Axial length (AL): 22.69 mm
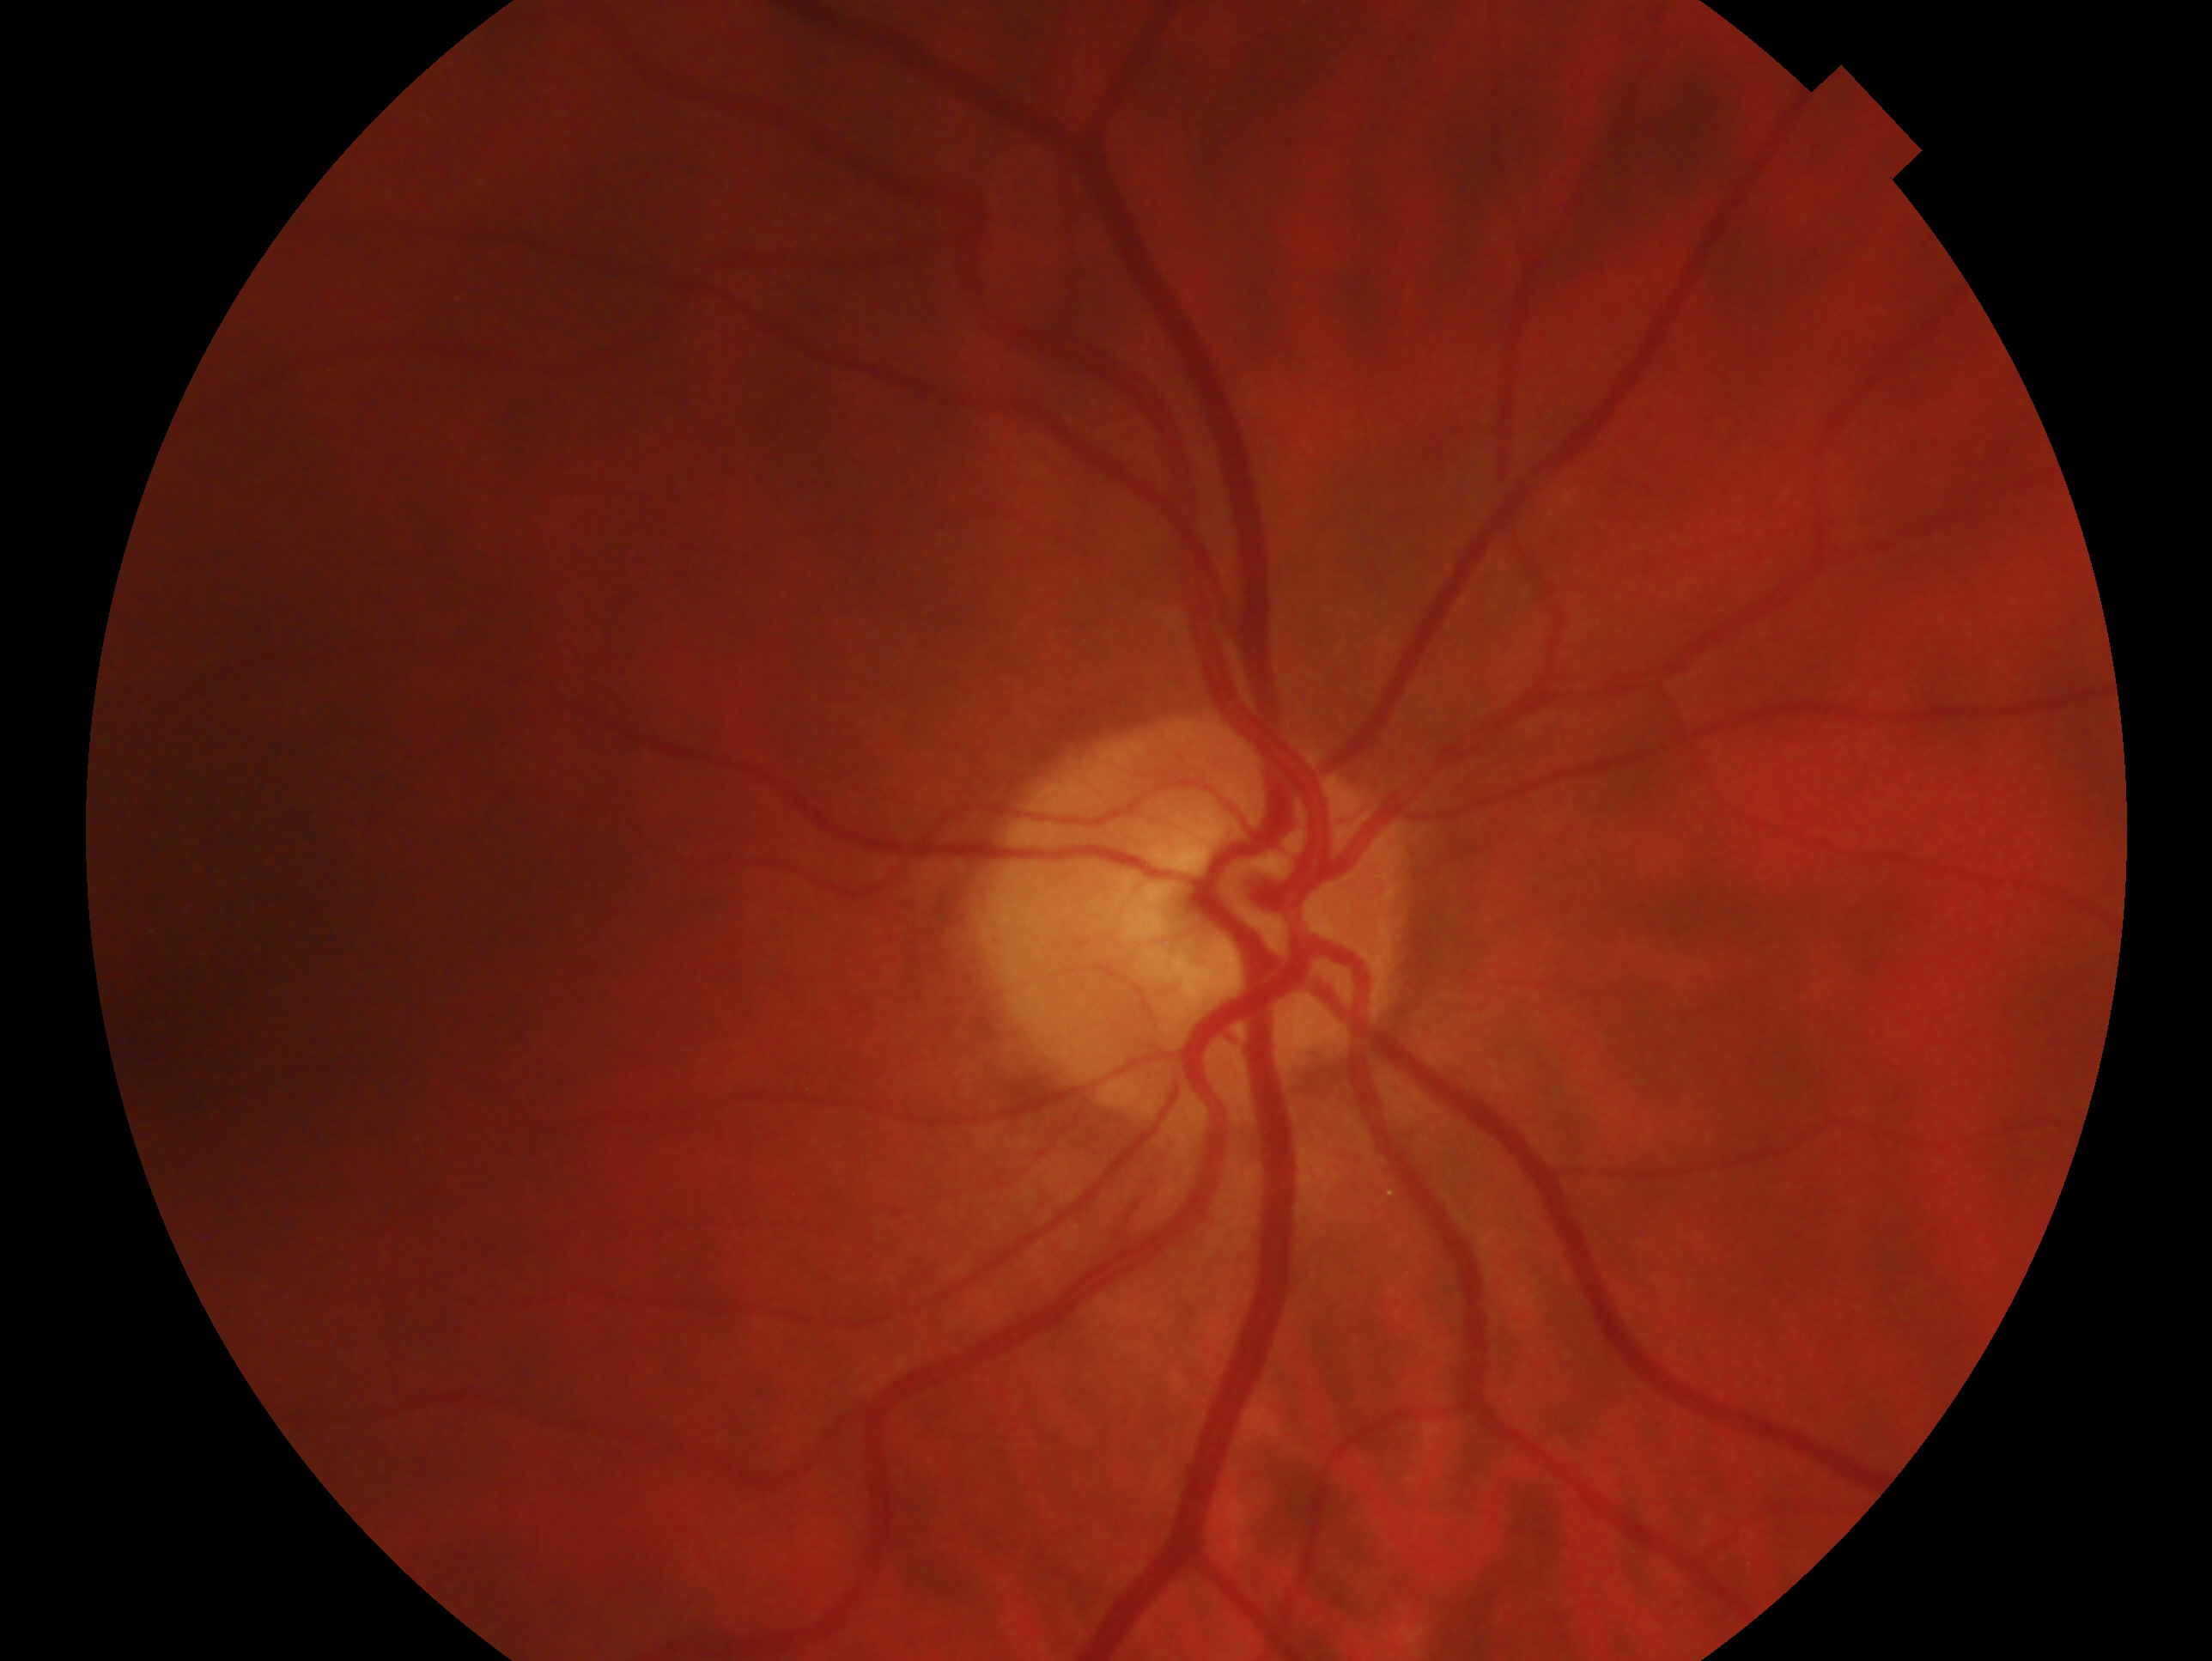 Imaged eye: right eye. Clinical classification: glaucomatous optic neuropathy.